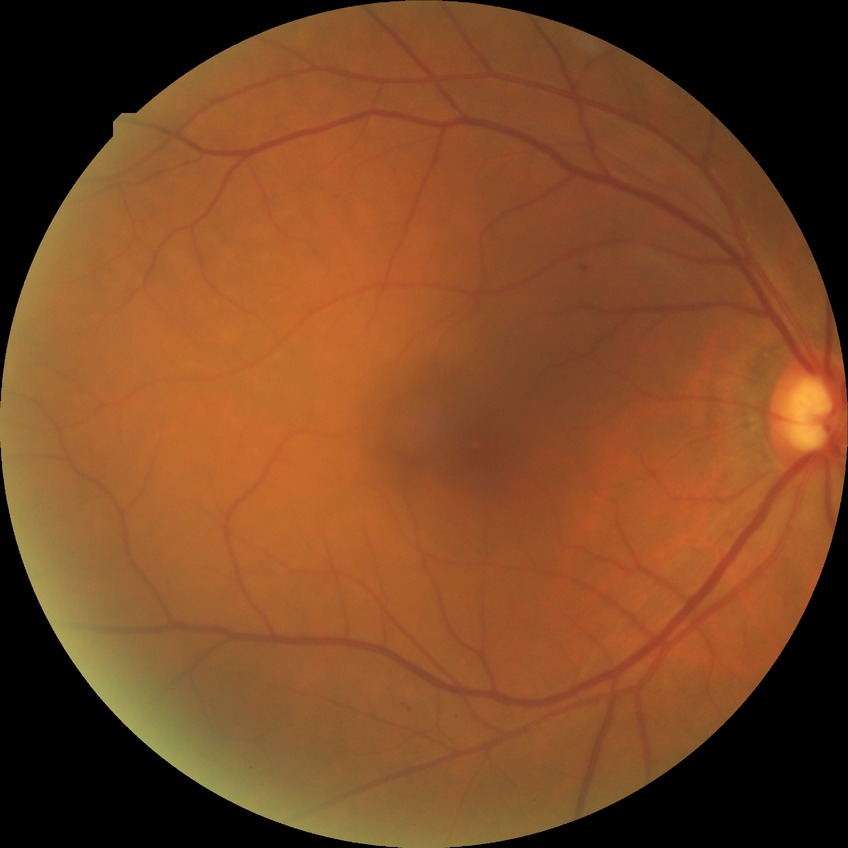
{
  "davis_grade": "SDR"
}